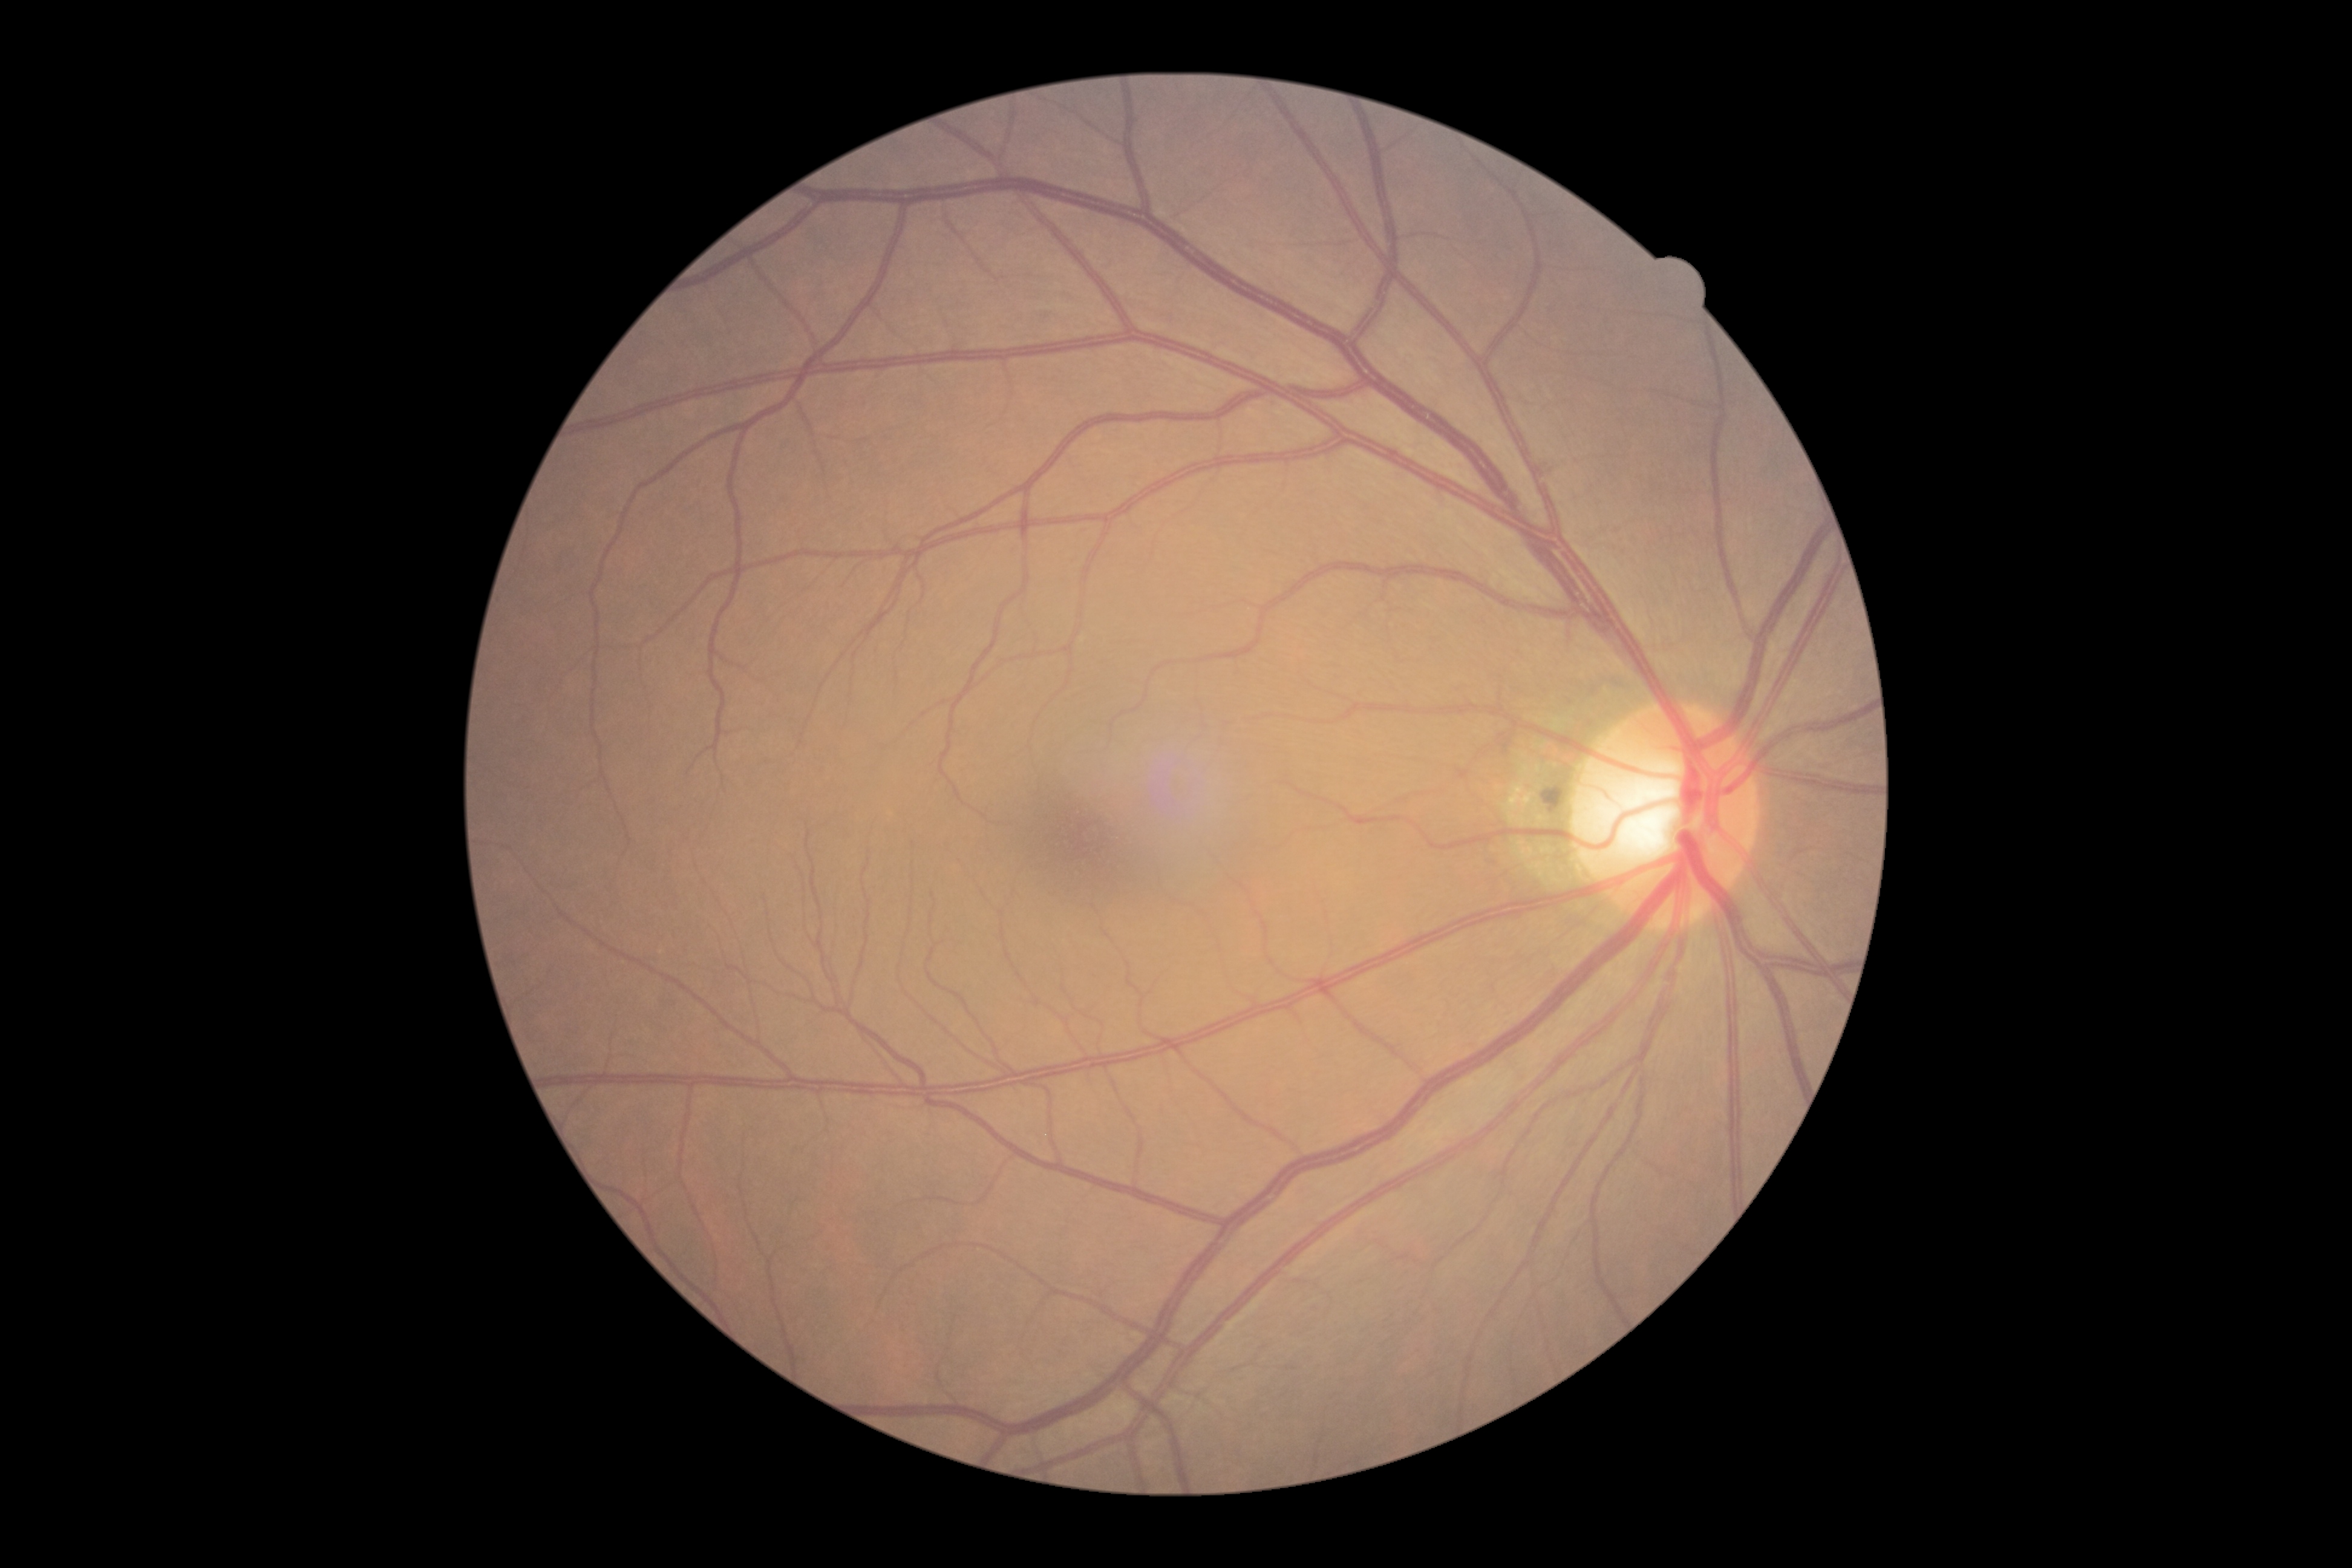

Diabetic retinopathy (DR): no apparent retinopathy (grade 0) — no visible signs of diabetic retinopathy.